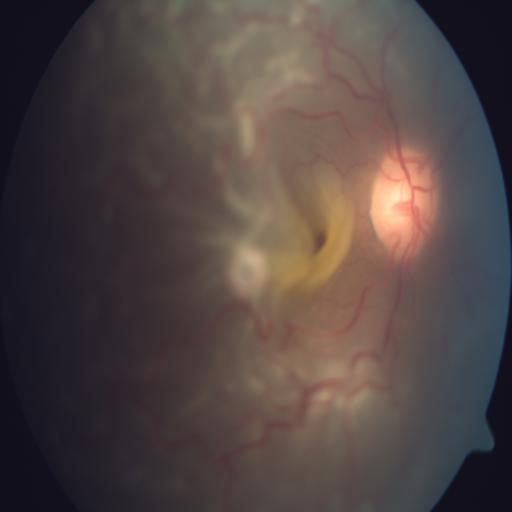 Fundus image with findings of retinal traction.